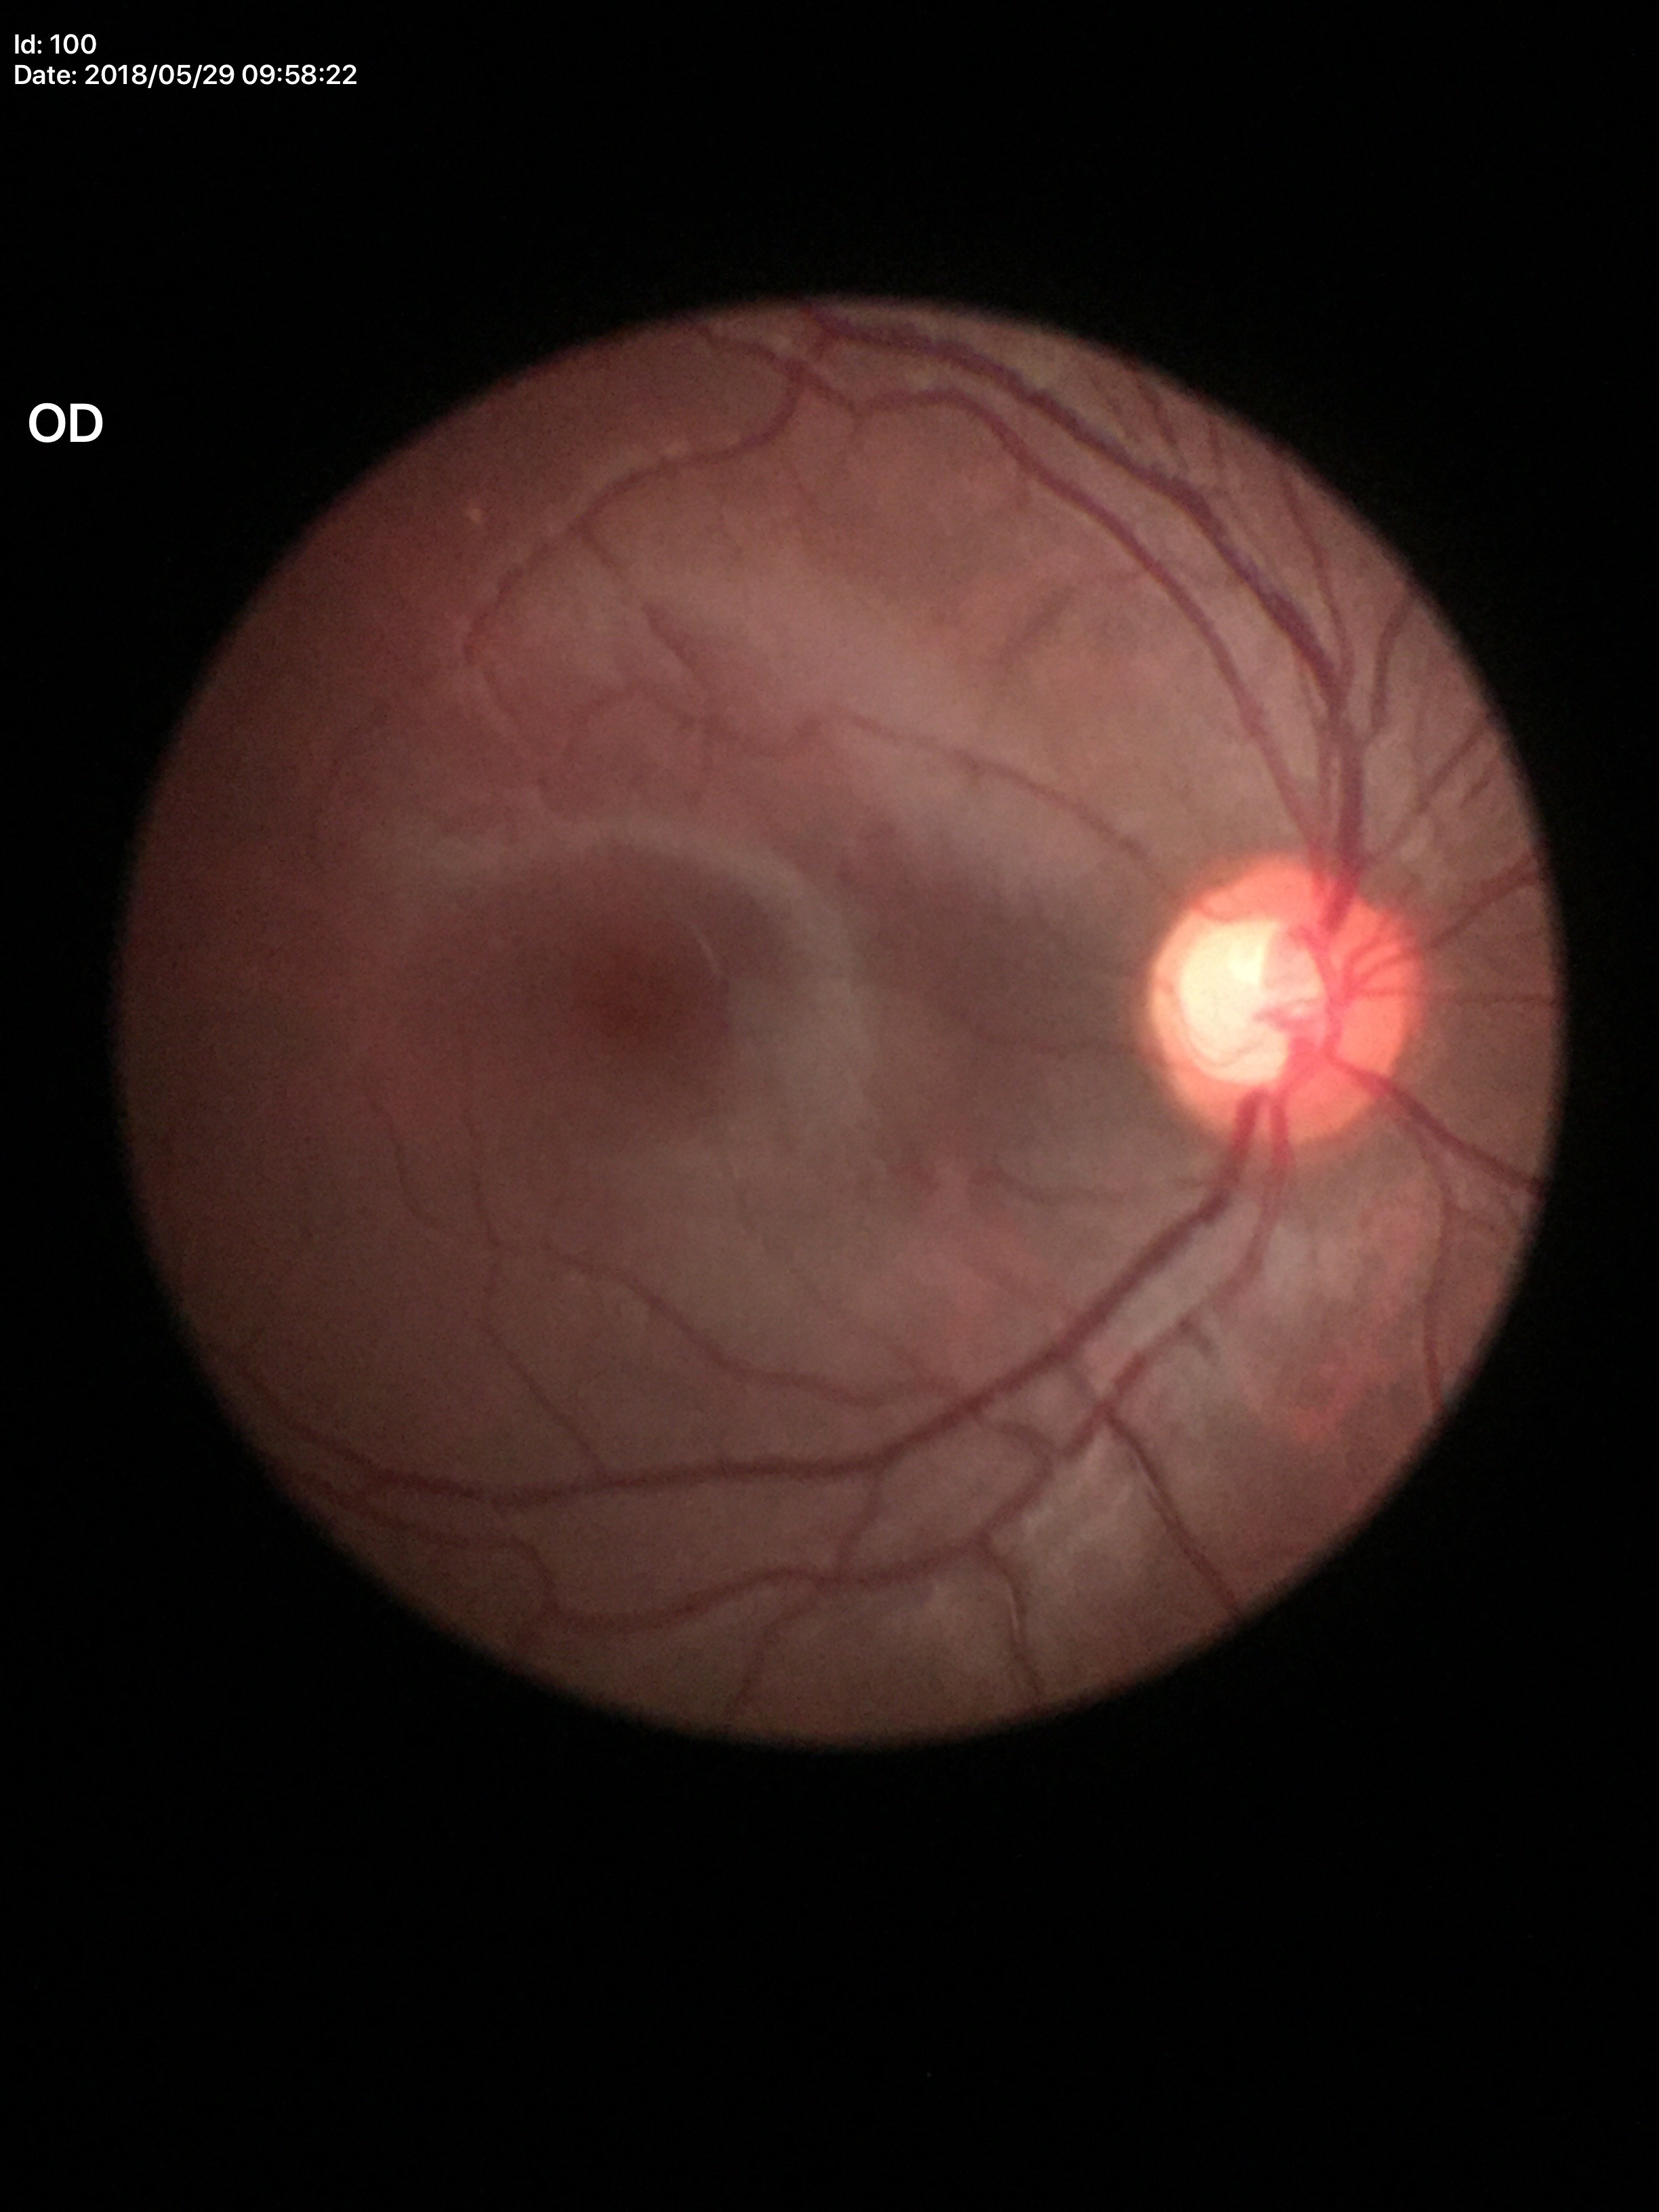
- Glaucoma screening impression — suspect
- vertical cup-to-disc ratio — 0.67